Pediatric retinal photograph (wide-field); 1240 x 1240 pixels; captured with the Phoenix ICON (100° field of view) — 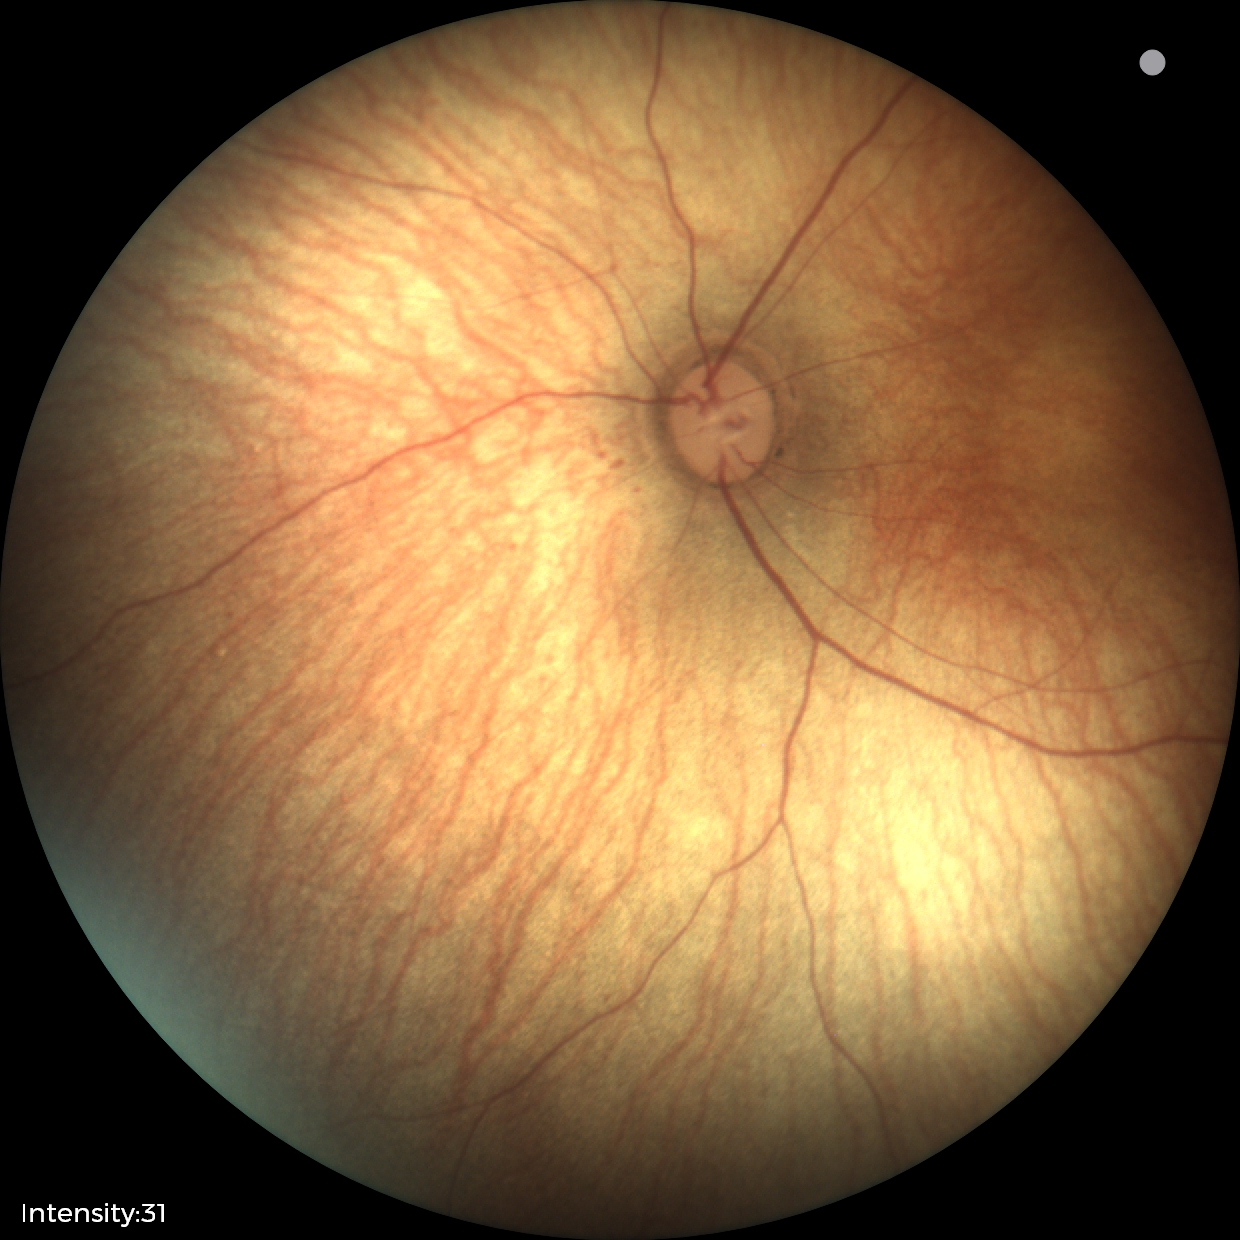
Q: What is the screening diagnosis?
A: no abnormal retinal findings